1240 x 1240 pixels. Wide-field fundus photograph of an infant — 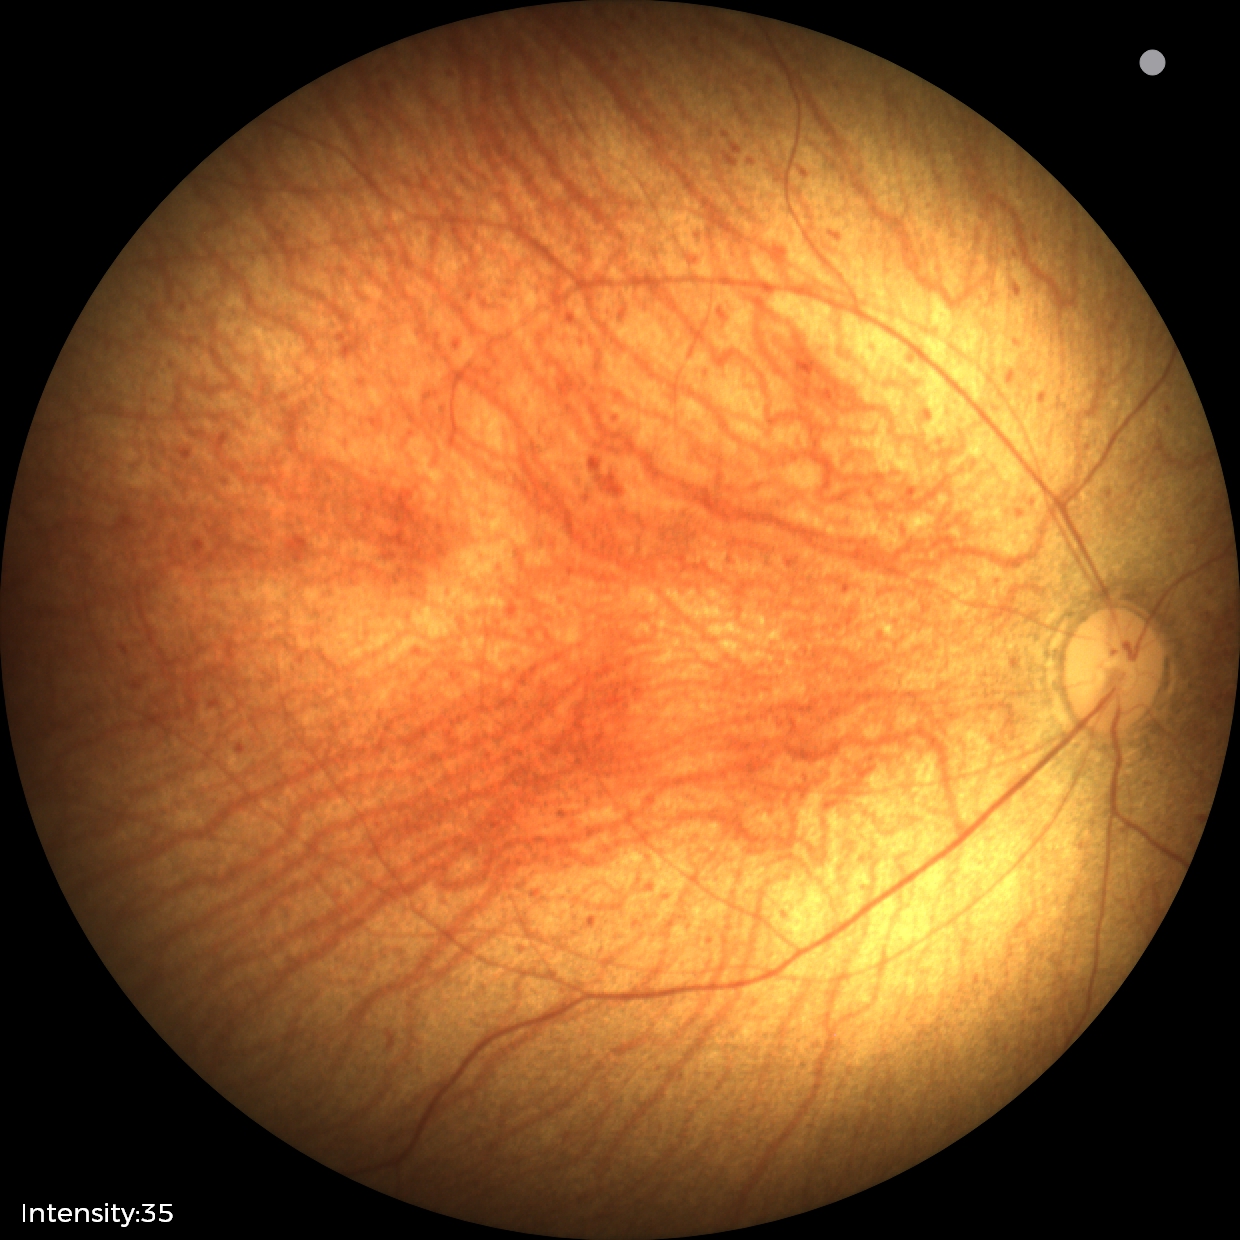 Q: What is the screening diagnosis?
A: physiological retinal finding